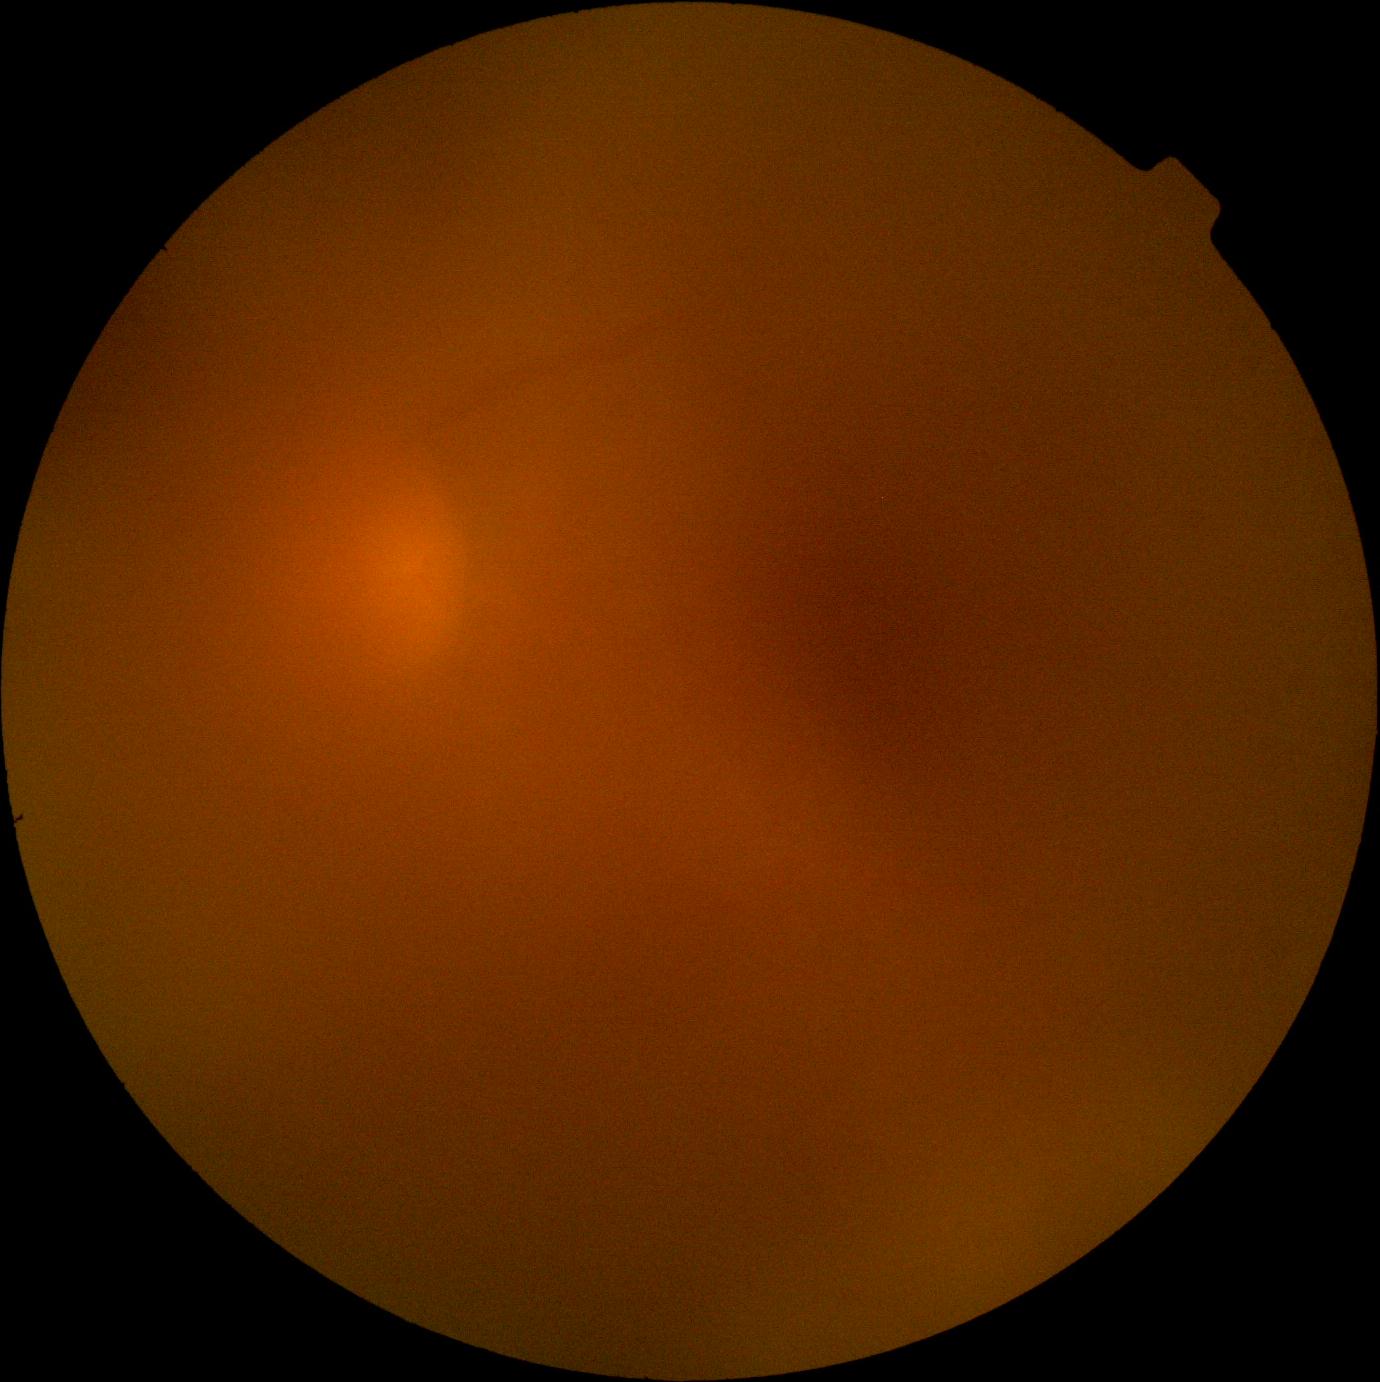
retinopathy grade: ungradable due to poor image quality.